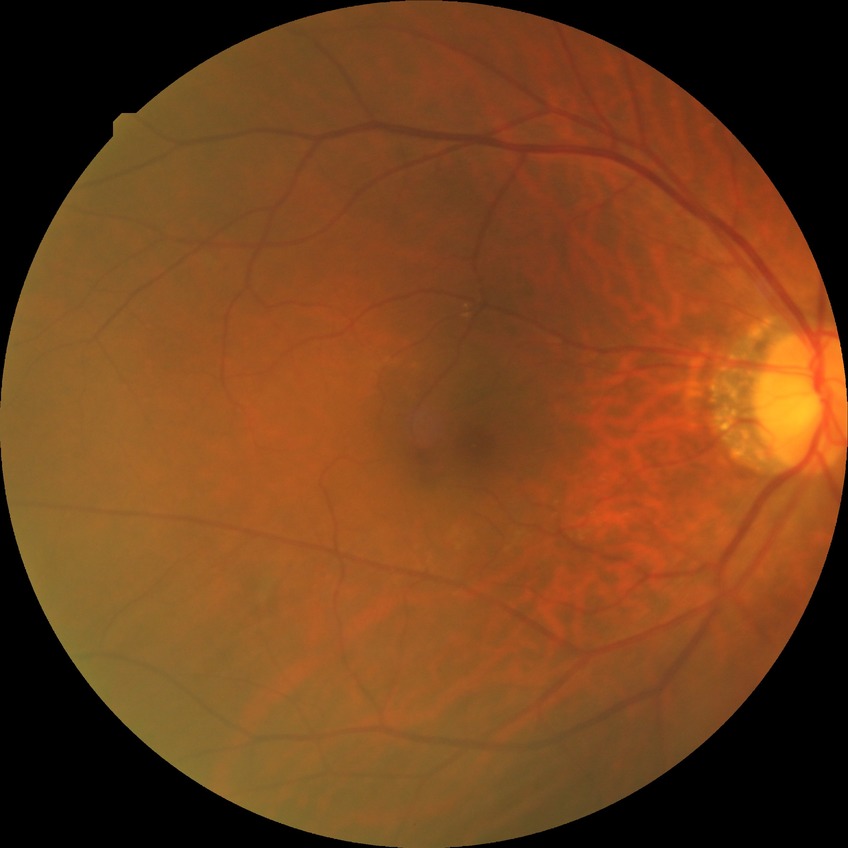

Diabetic retinopathy (DR): NDR (no diabetic retinopathy).